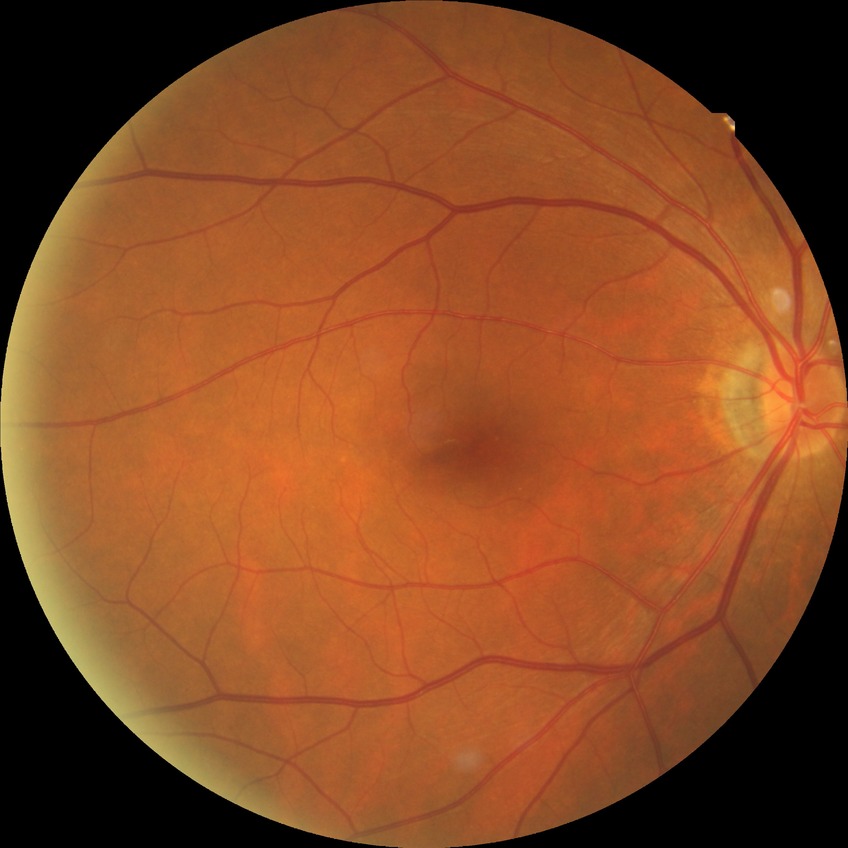
DR severity=NDR.